Wide-field fundus image from infant ROP screening. 640 by 480 pixels: 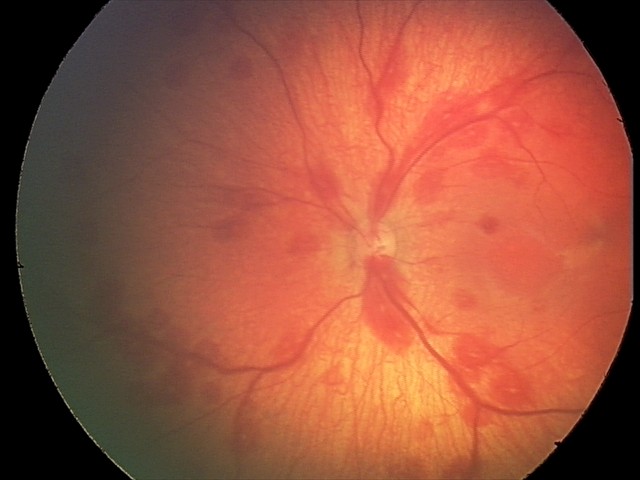

Q: What is the diagnosis from this examination?
A: retinal hemorrhages